RetCam wide-field infant fundus image:
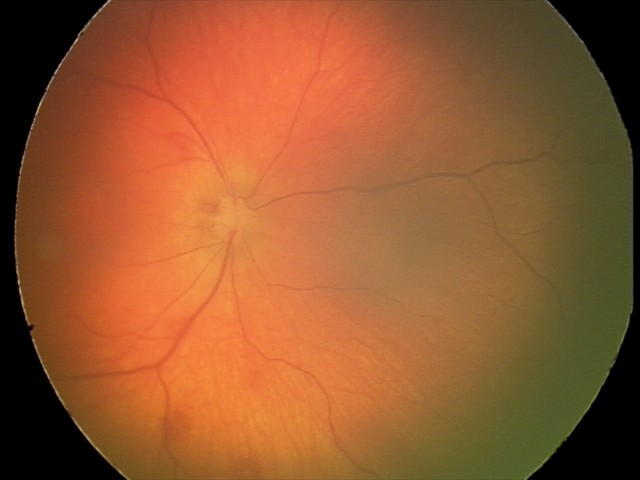 Examination diagnosed as retinal hemorrhages.